CFP:
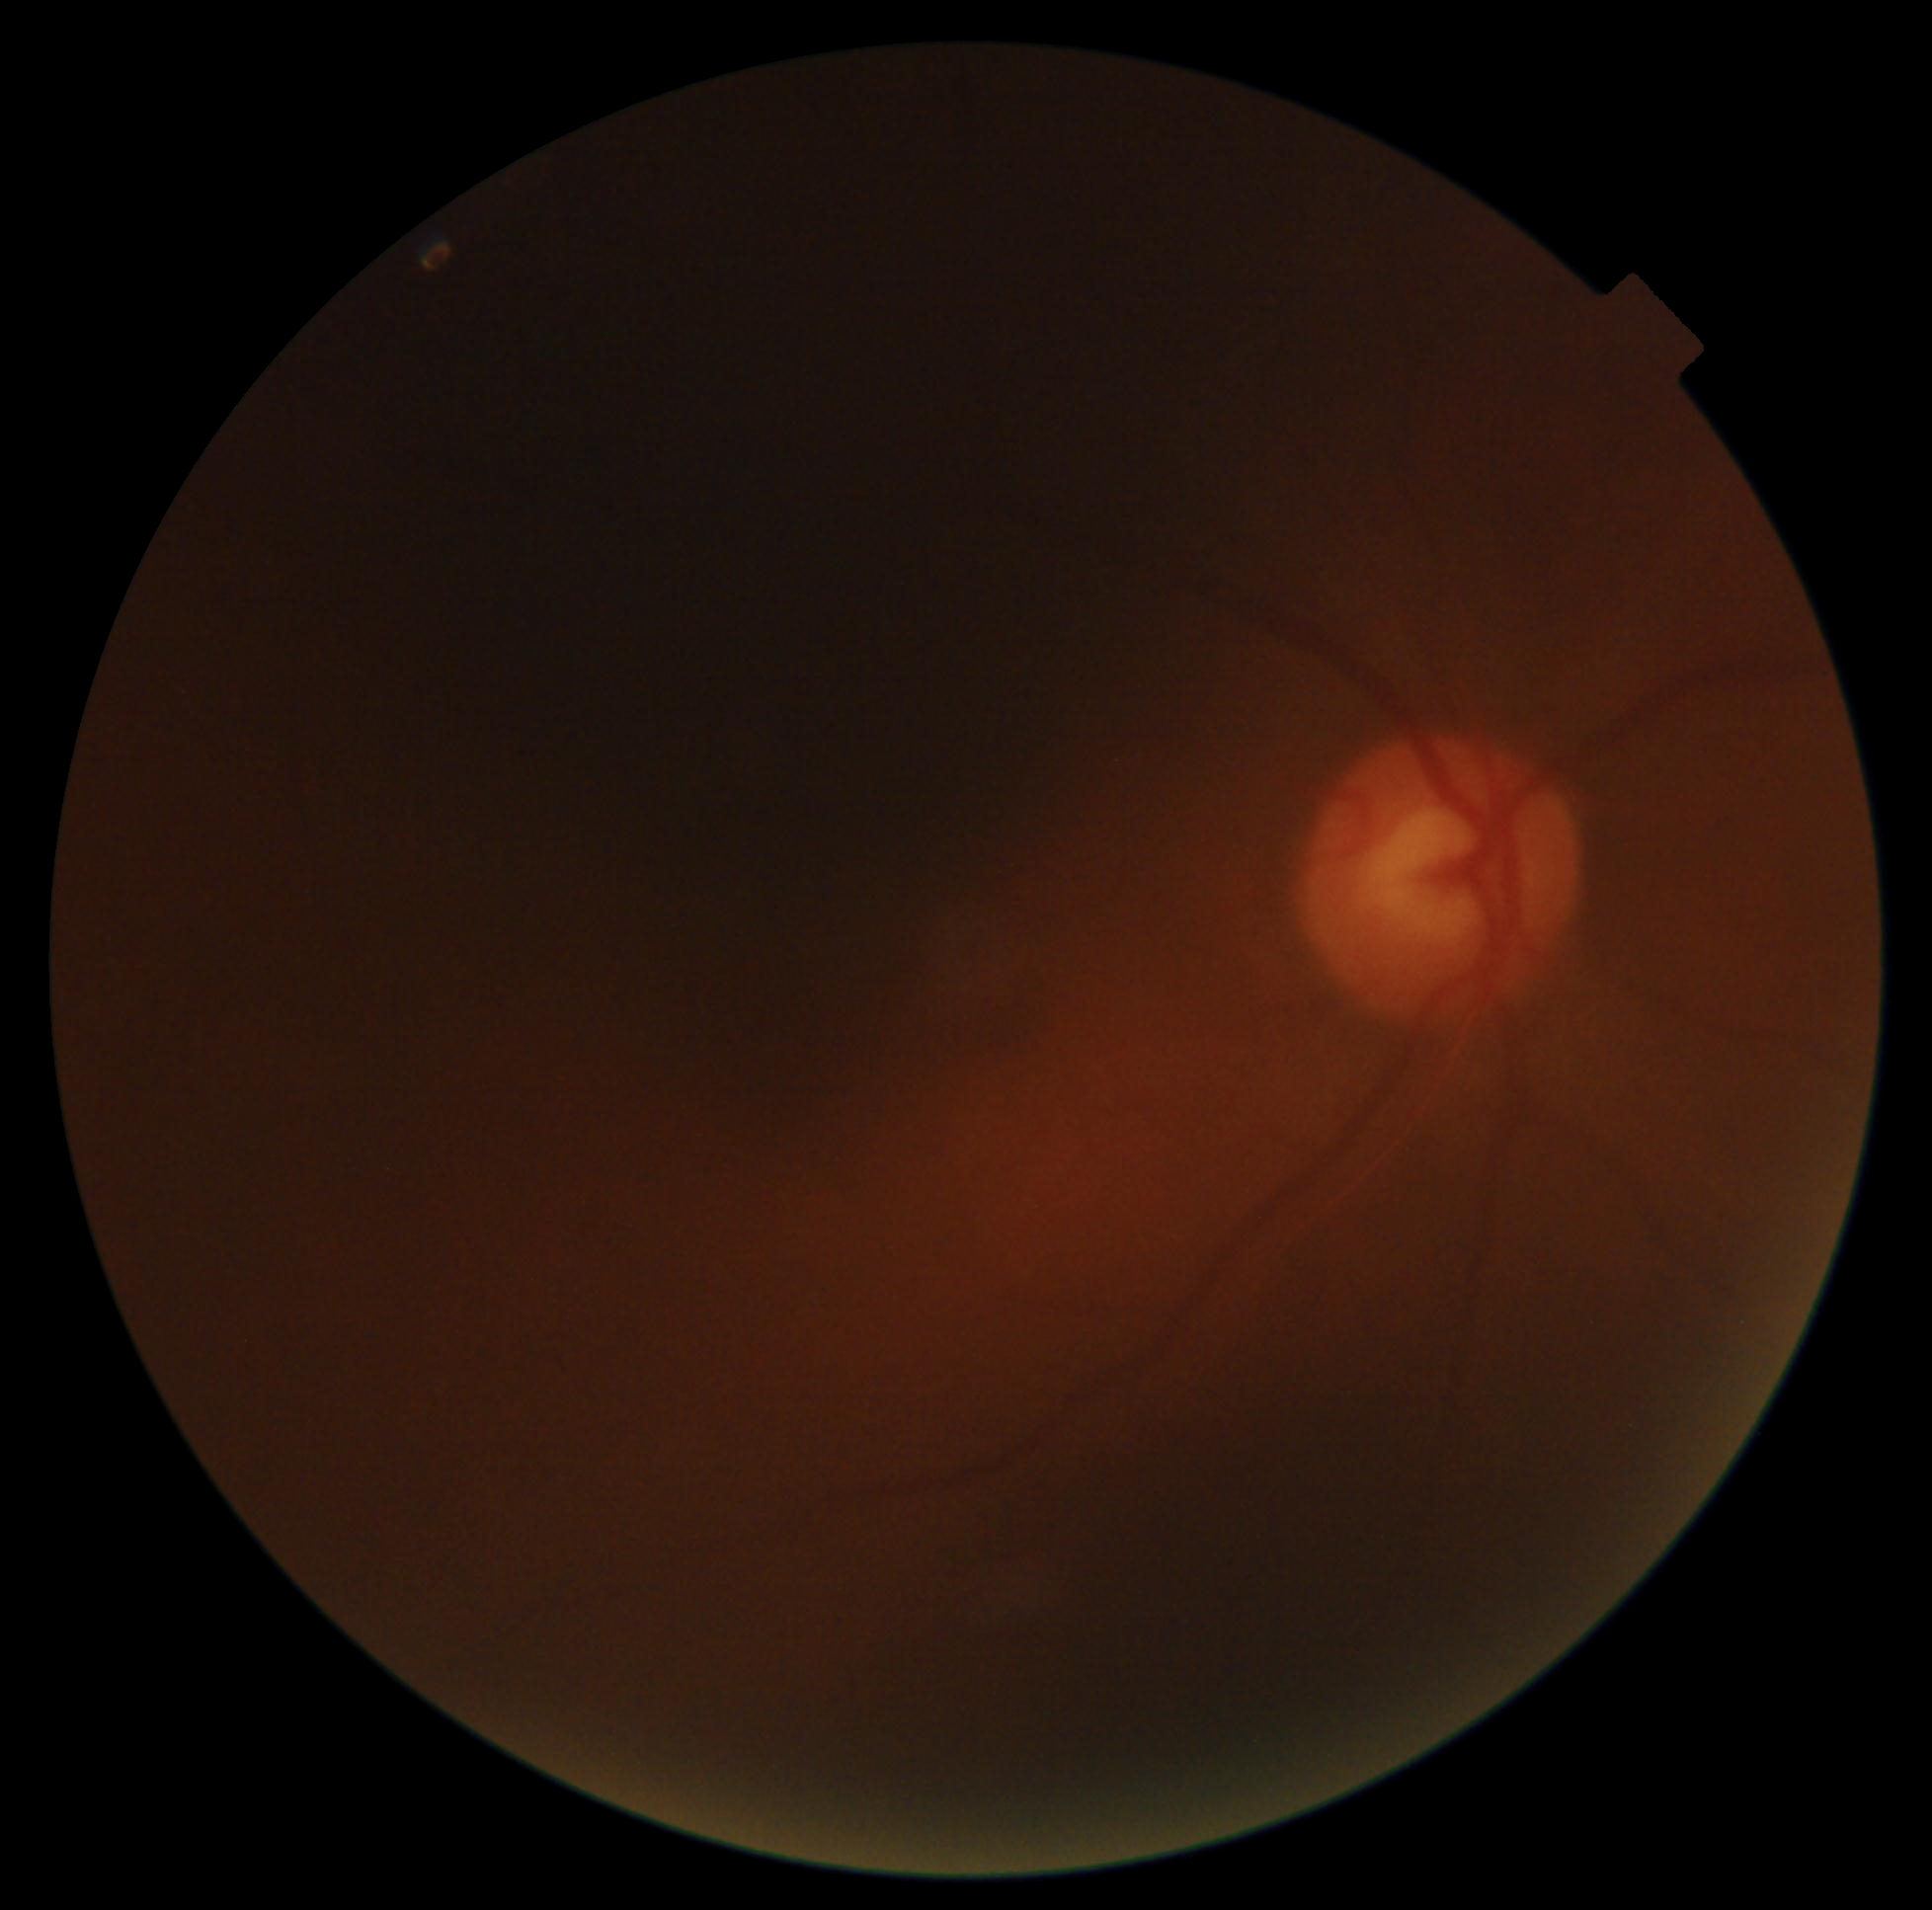

image quality = insufficient for DR assessment; diabetic retinopathy (DR) = ungradable due to poor image quality.